Wide-field fundus image from infant ROP screening: 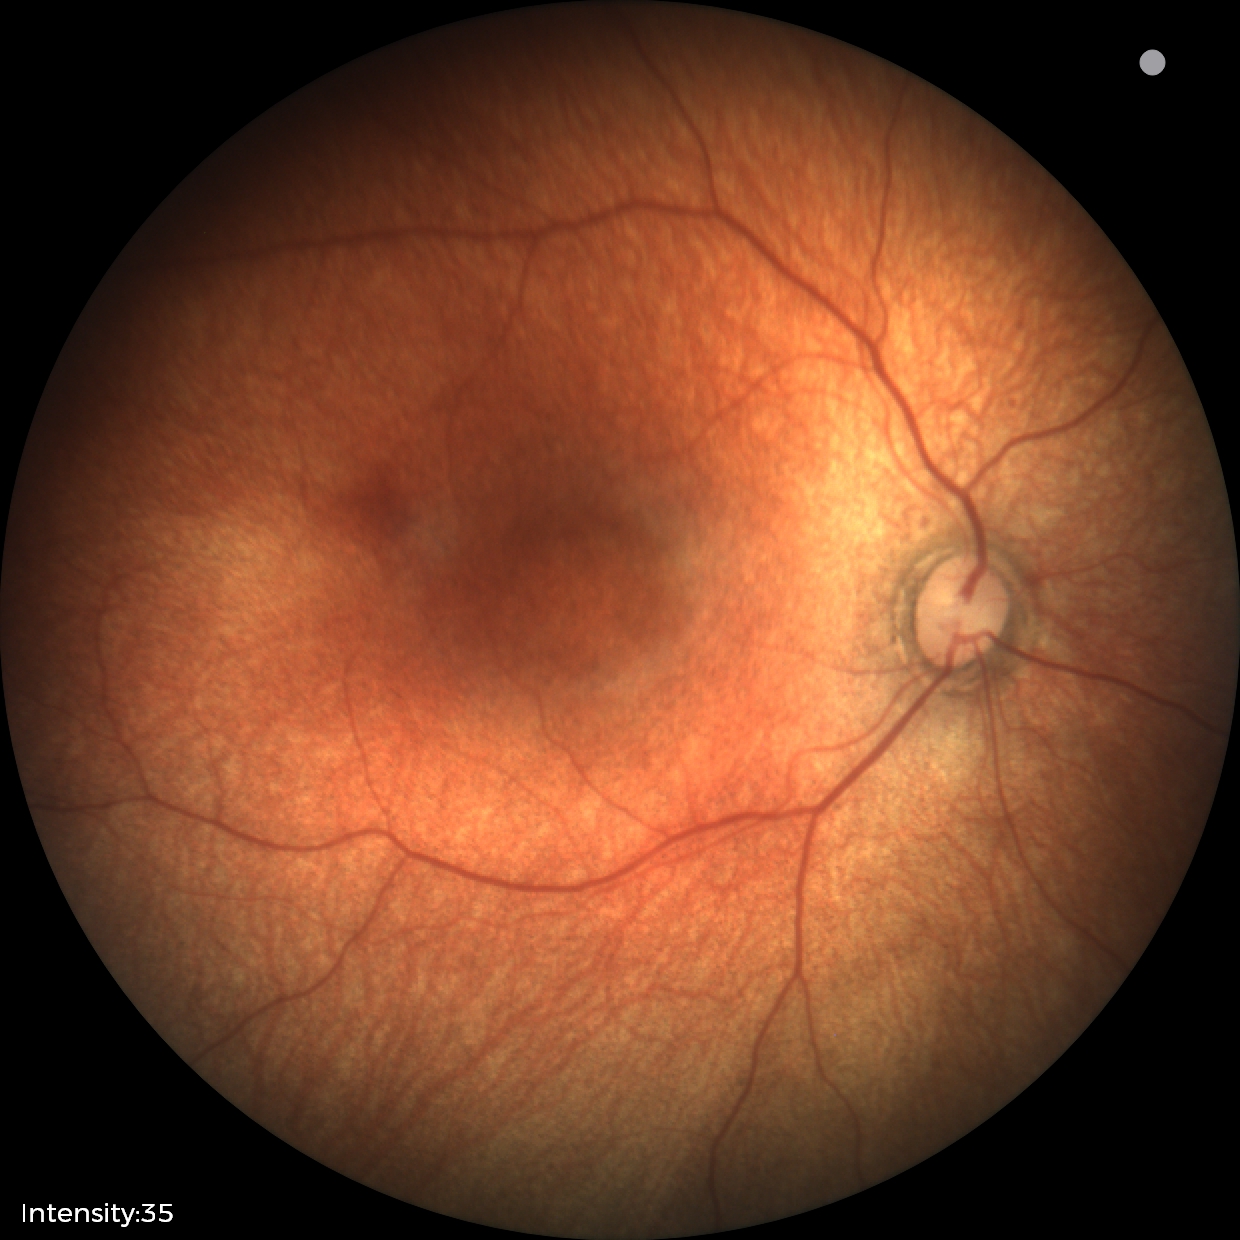

Screening examination with no abnormal retinal findings.